Color fundus photograph, 45-degree field of view
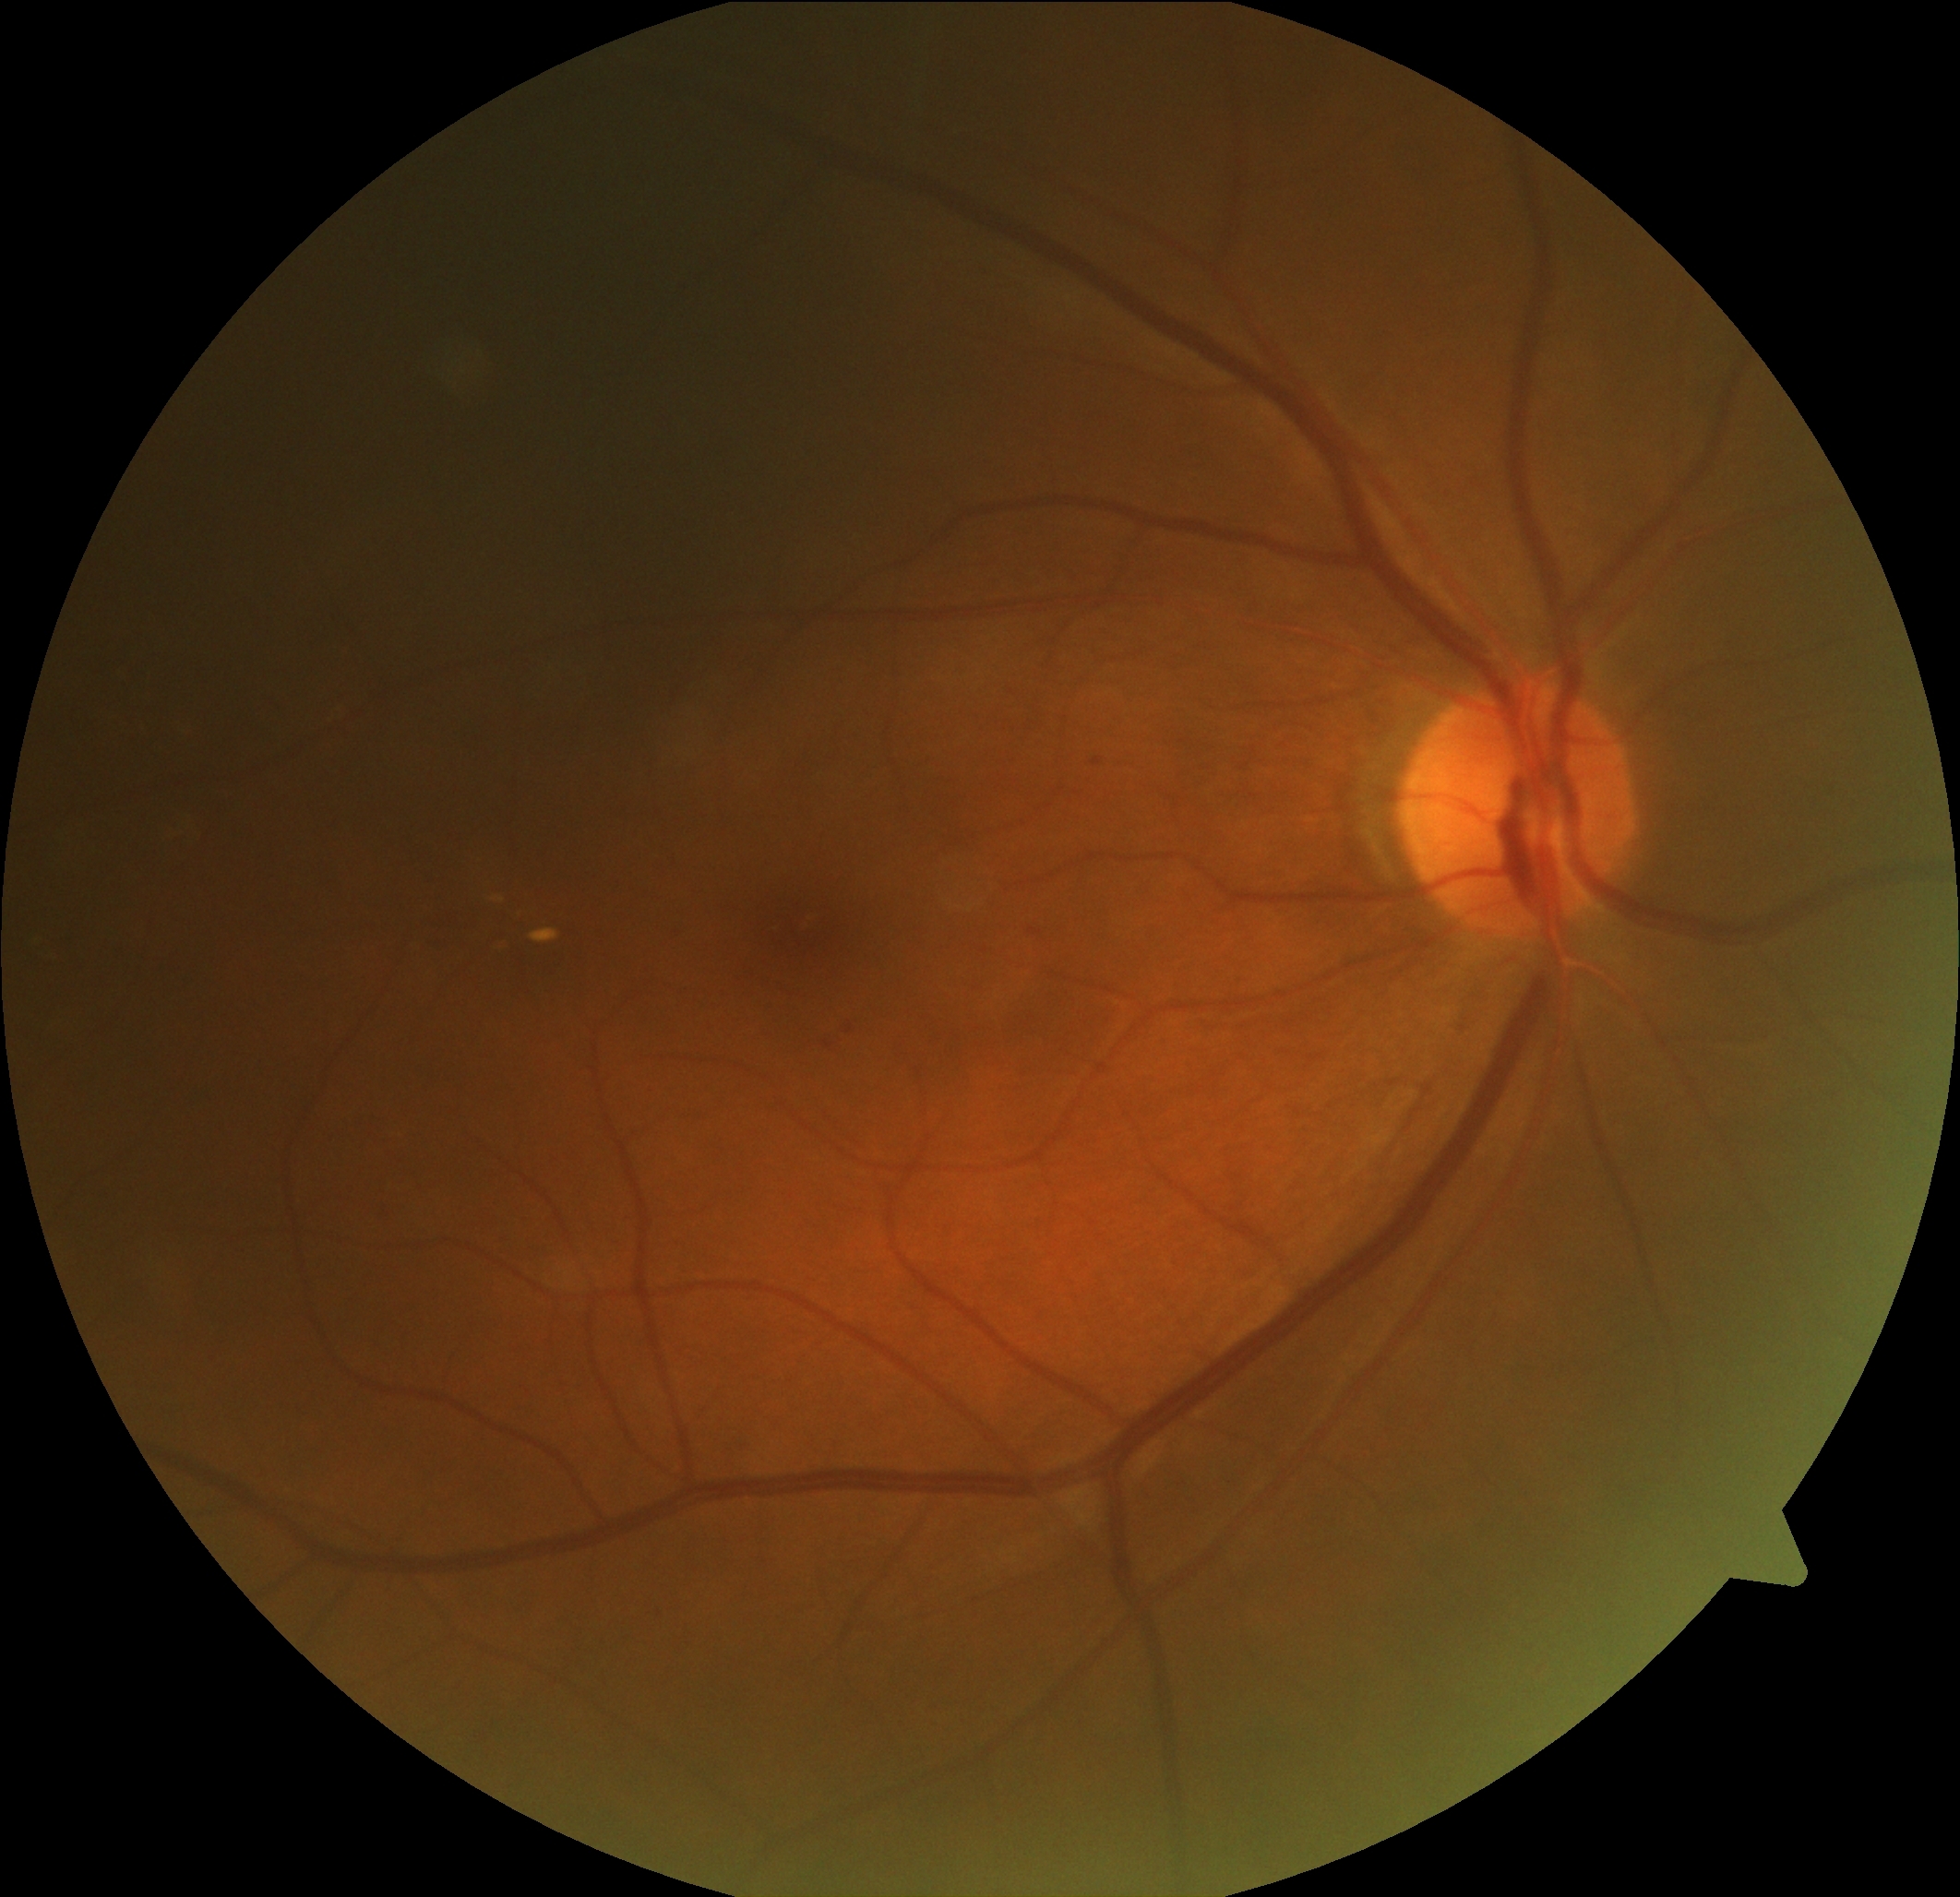
  dr_category: non-proliferative diabetic retinopathy
  dr_grade: moderate NPDR (grade 2)